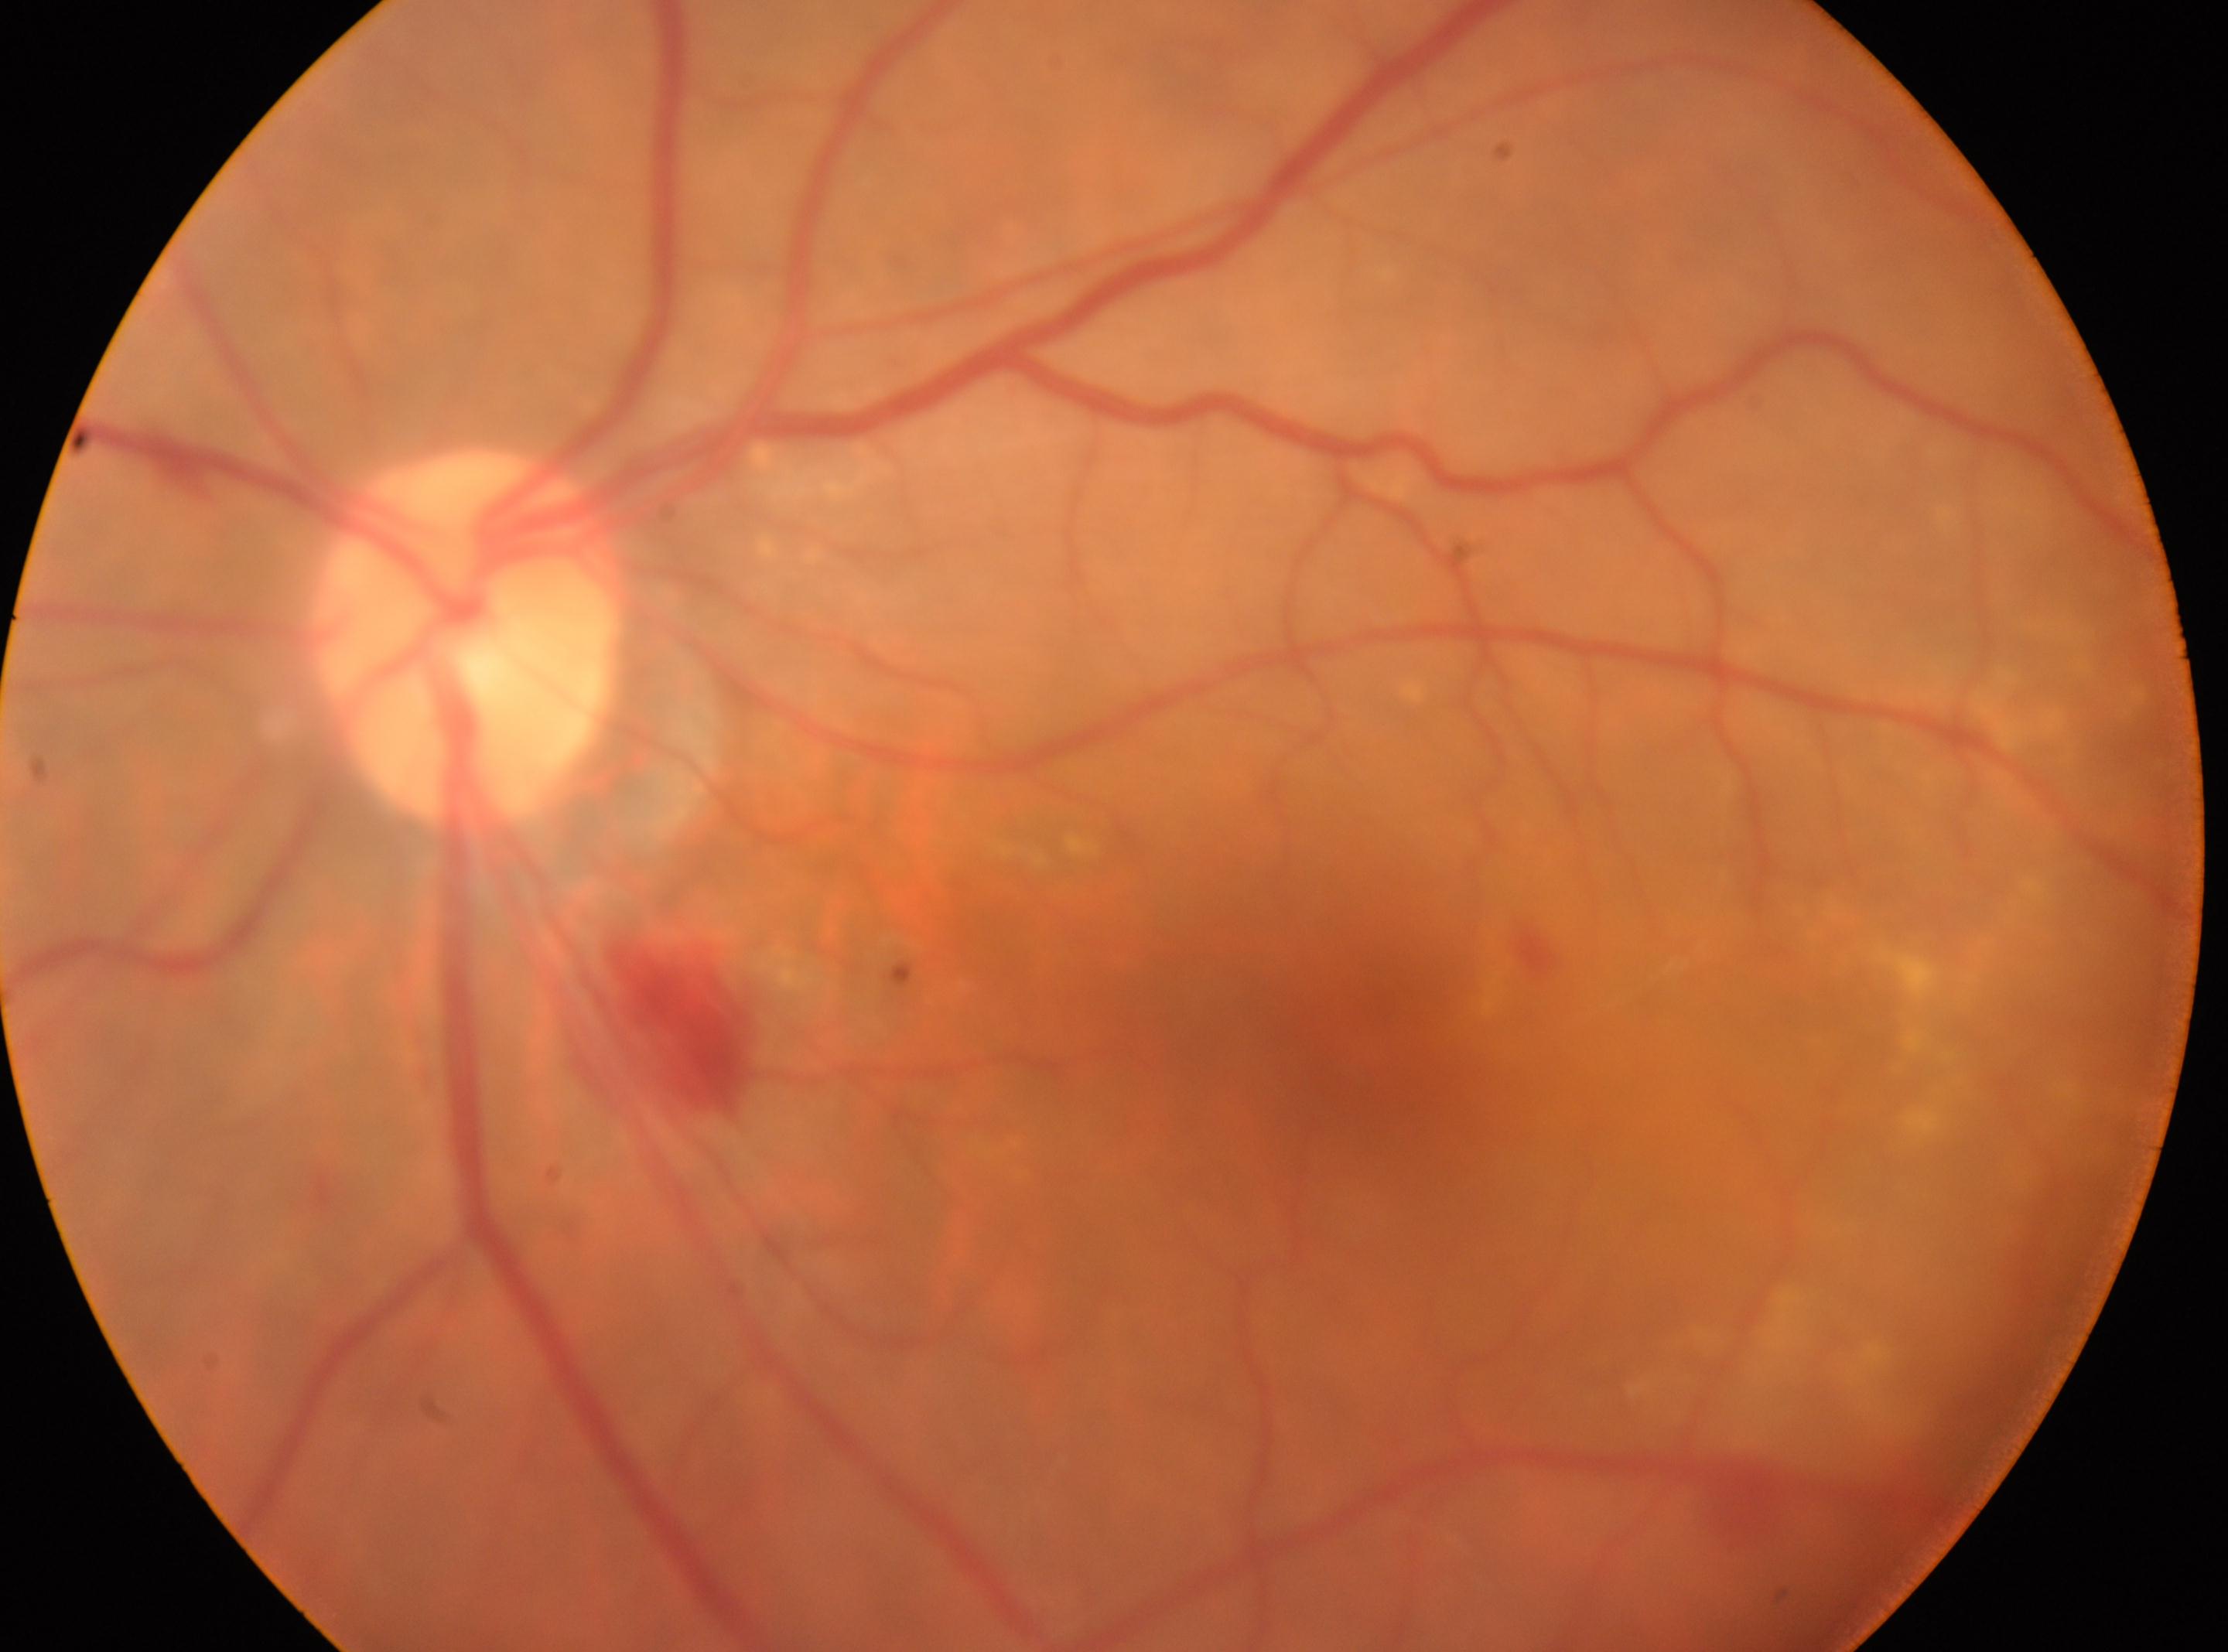 Findings:
– the optic disc · [463, 637]
– macular center · [1354, 1021]
– DR · 2
– laterality · left eye